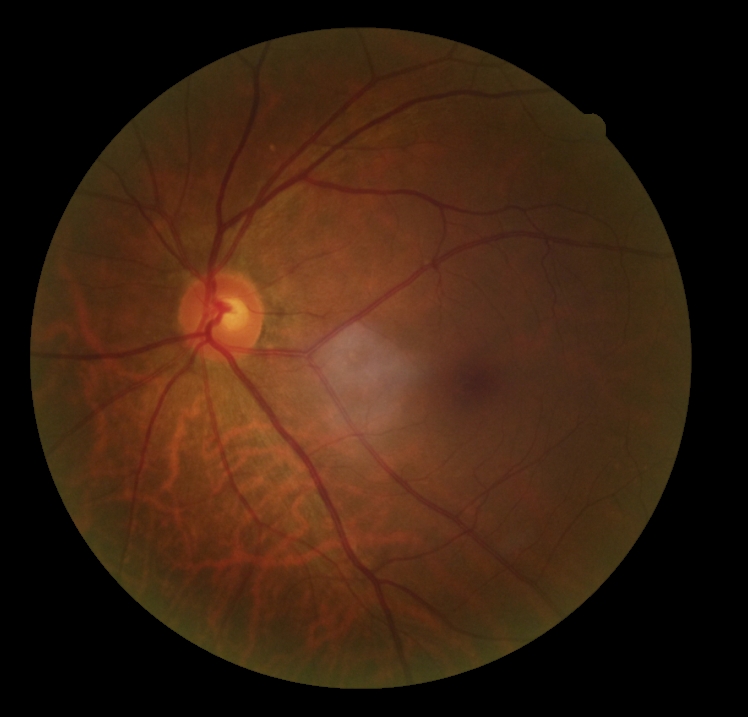
Diabetic retinopathy (DR): grade 0 (no apparent retinopathy).